Wide-field fundus image from infant ROP screening.
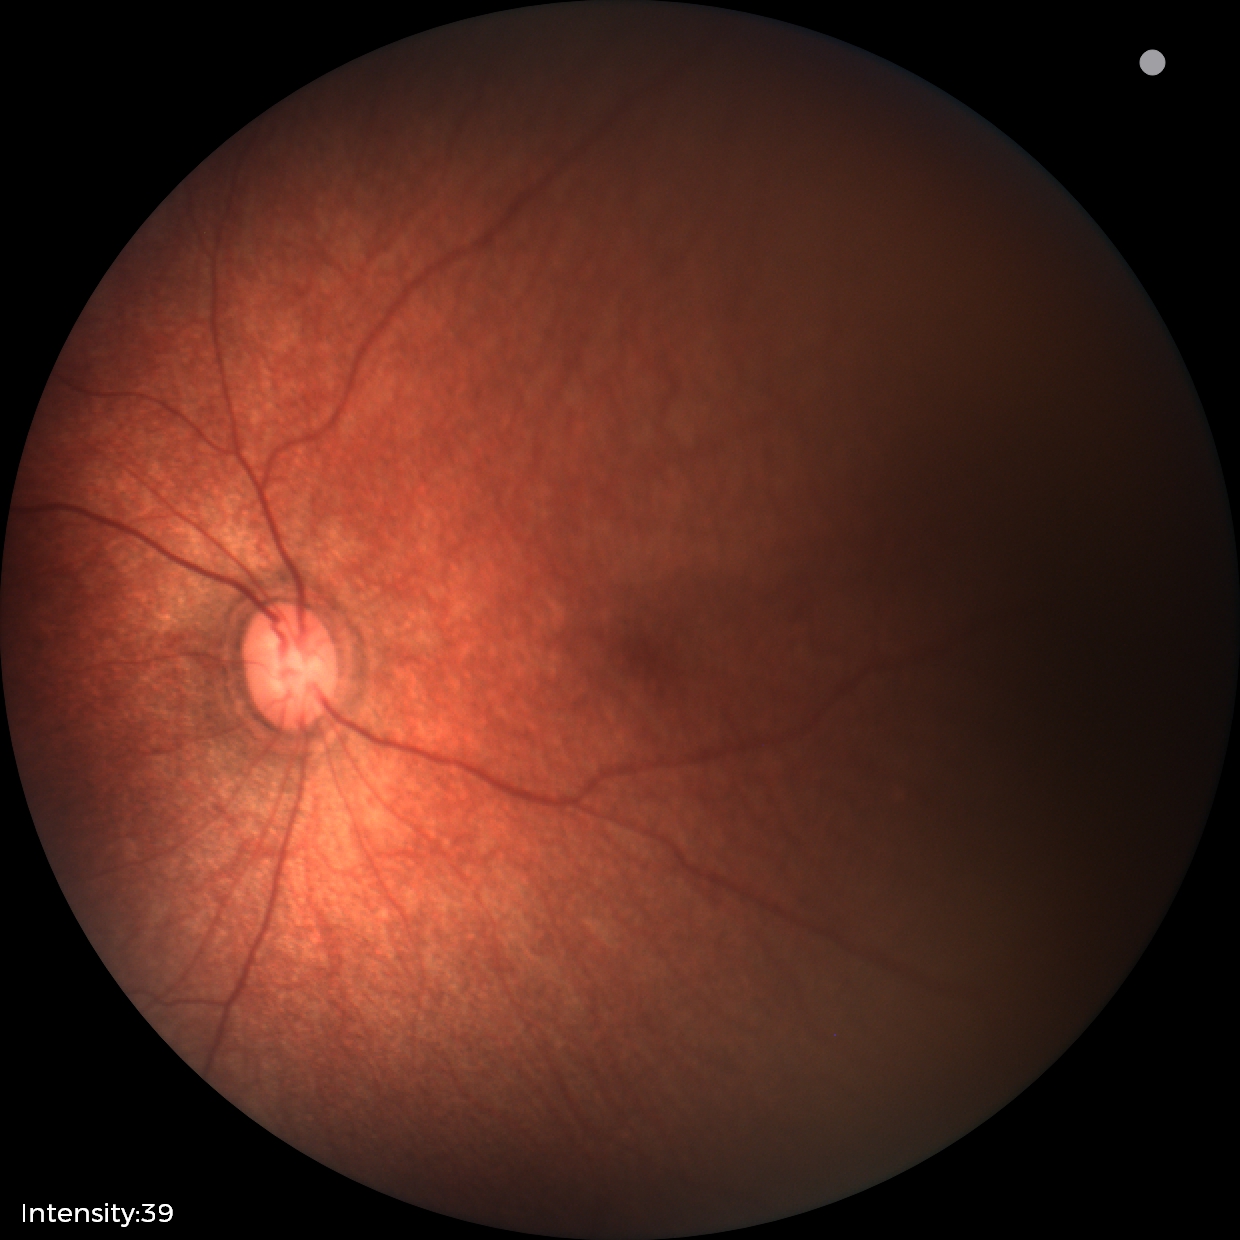
Q: What was the screening finding?
A: normal retinal appearance